Color fundus photograph — 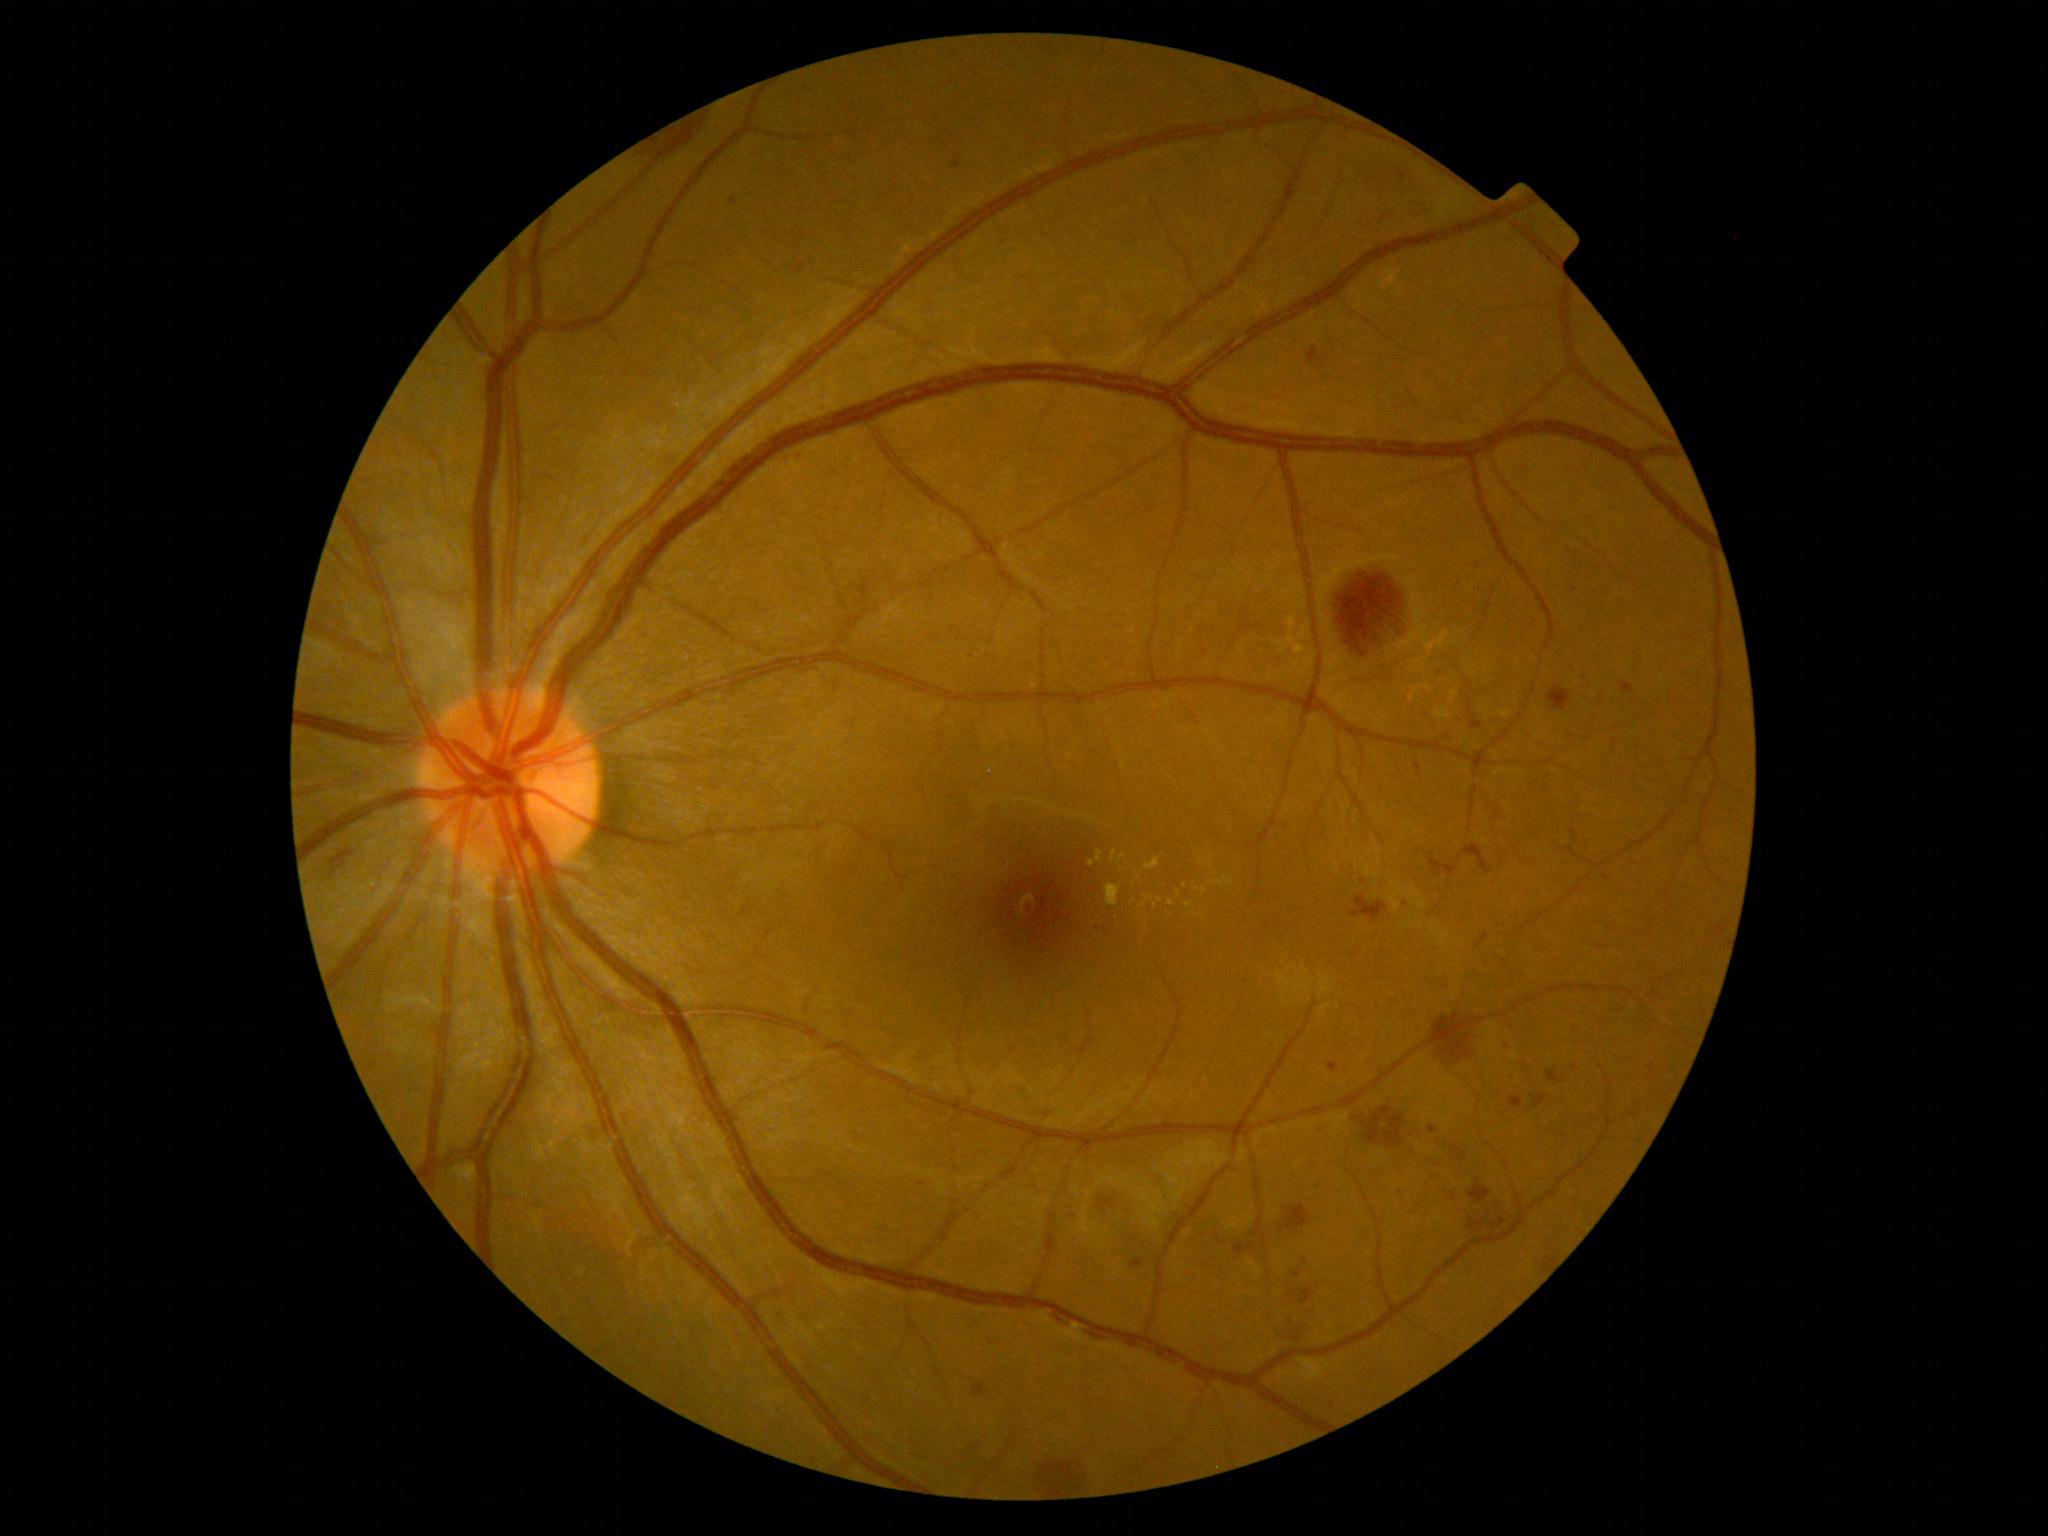
DR is grade 2 (moderate NPDR)
Representative lesions:
EXs (more not shown): 1202, 886, 1208, 894; 1132, 878, 1141, 888; 1118, 854, 1128, 865; 1145, 858, 1161, 871
Additional small EXs near 1092, 863; 1148, 897; 1160, 900; 1136, 872; 1170, 903; 1186, 885
HEs (more not shown): 1469, 1220, 1486, 1233; 1235, 1244, 1254, 1256; 1353, 896, 1388, 922; 1430, 1012, 1470, 1061; 1549, 686, 1572, 712; 1282, 1204, 1312, 1231; 1547, 1070, 1562, 1084; 1469, 1184, 1492, 1203; 1471, 719, 1483, 729; 1532, 1094, 1546, 1108; 1477, 934, 1489, 948; 328, 849, 354, 872
Additional small HEs near 1607, 878